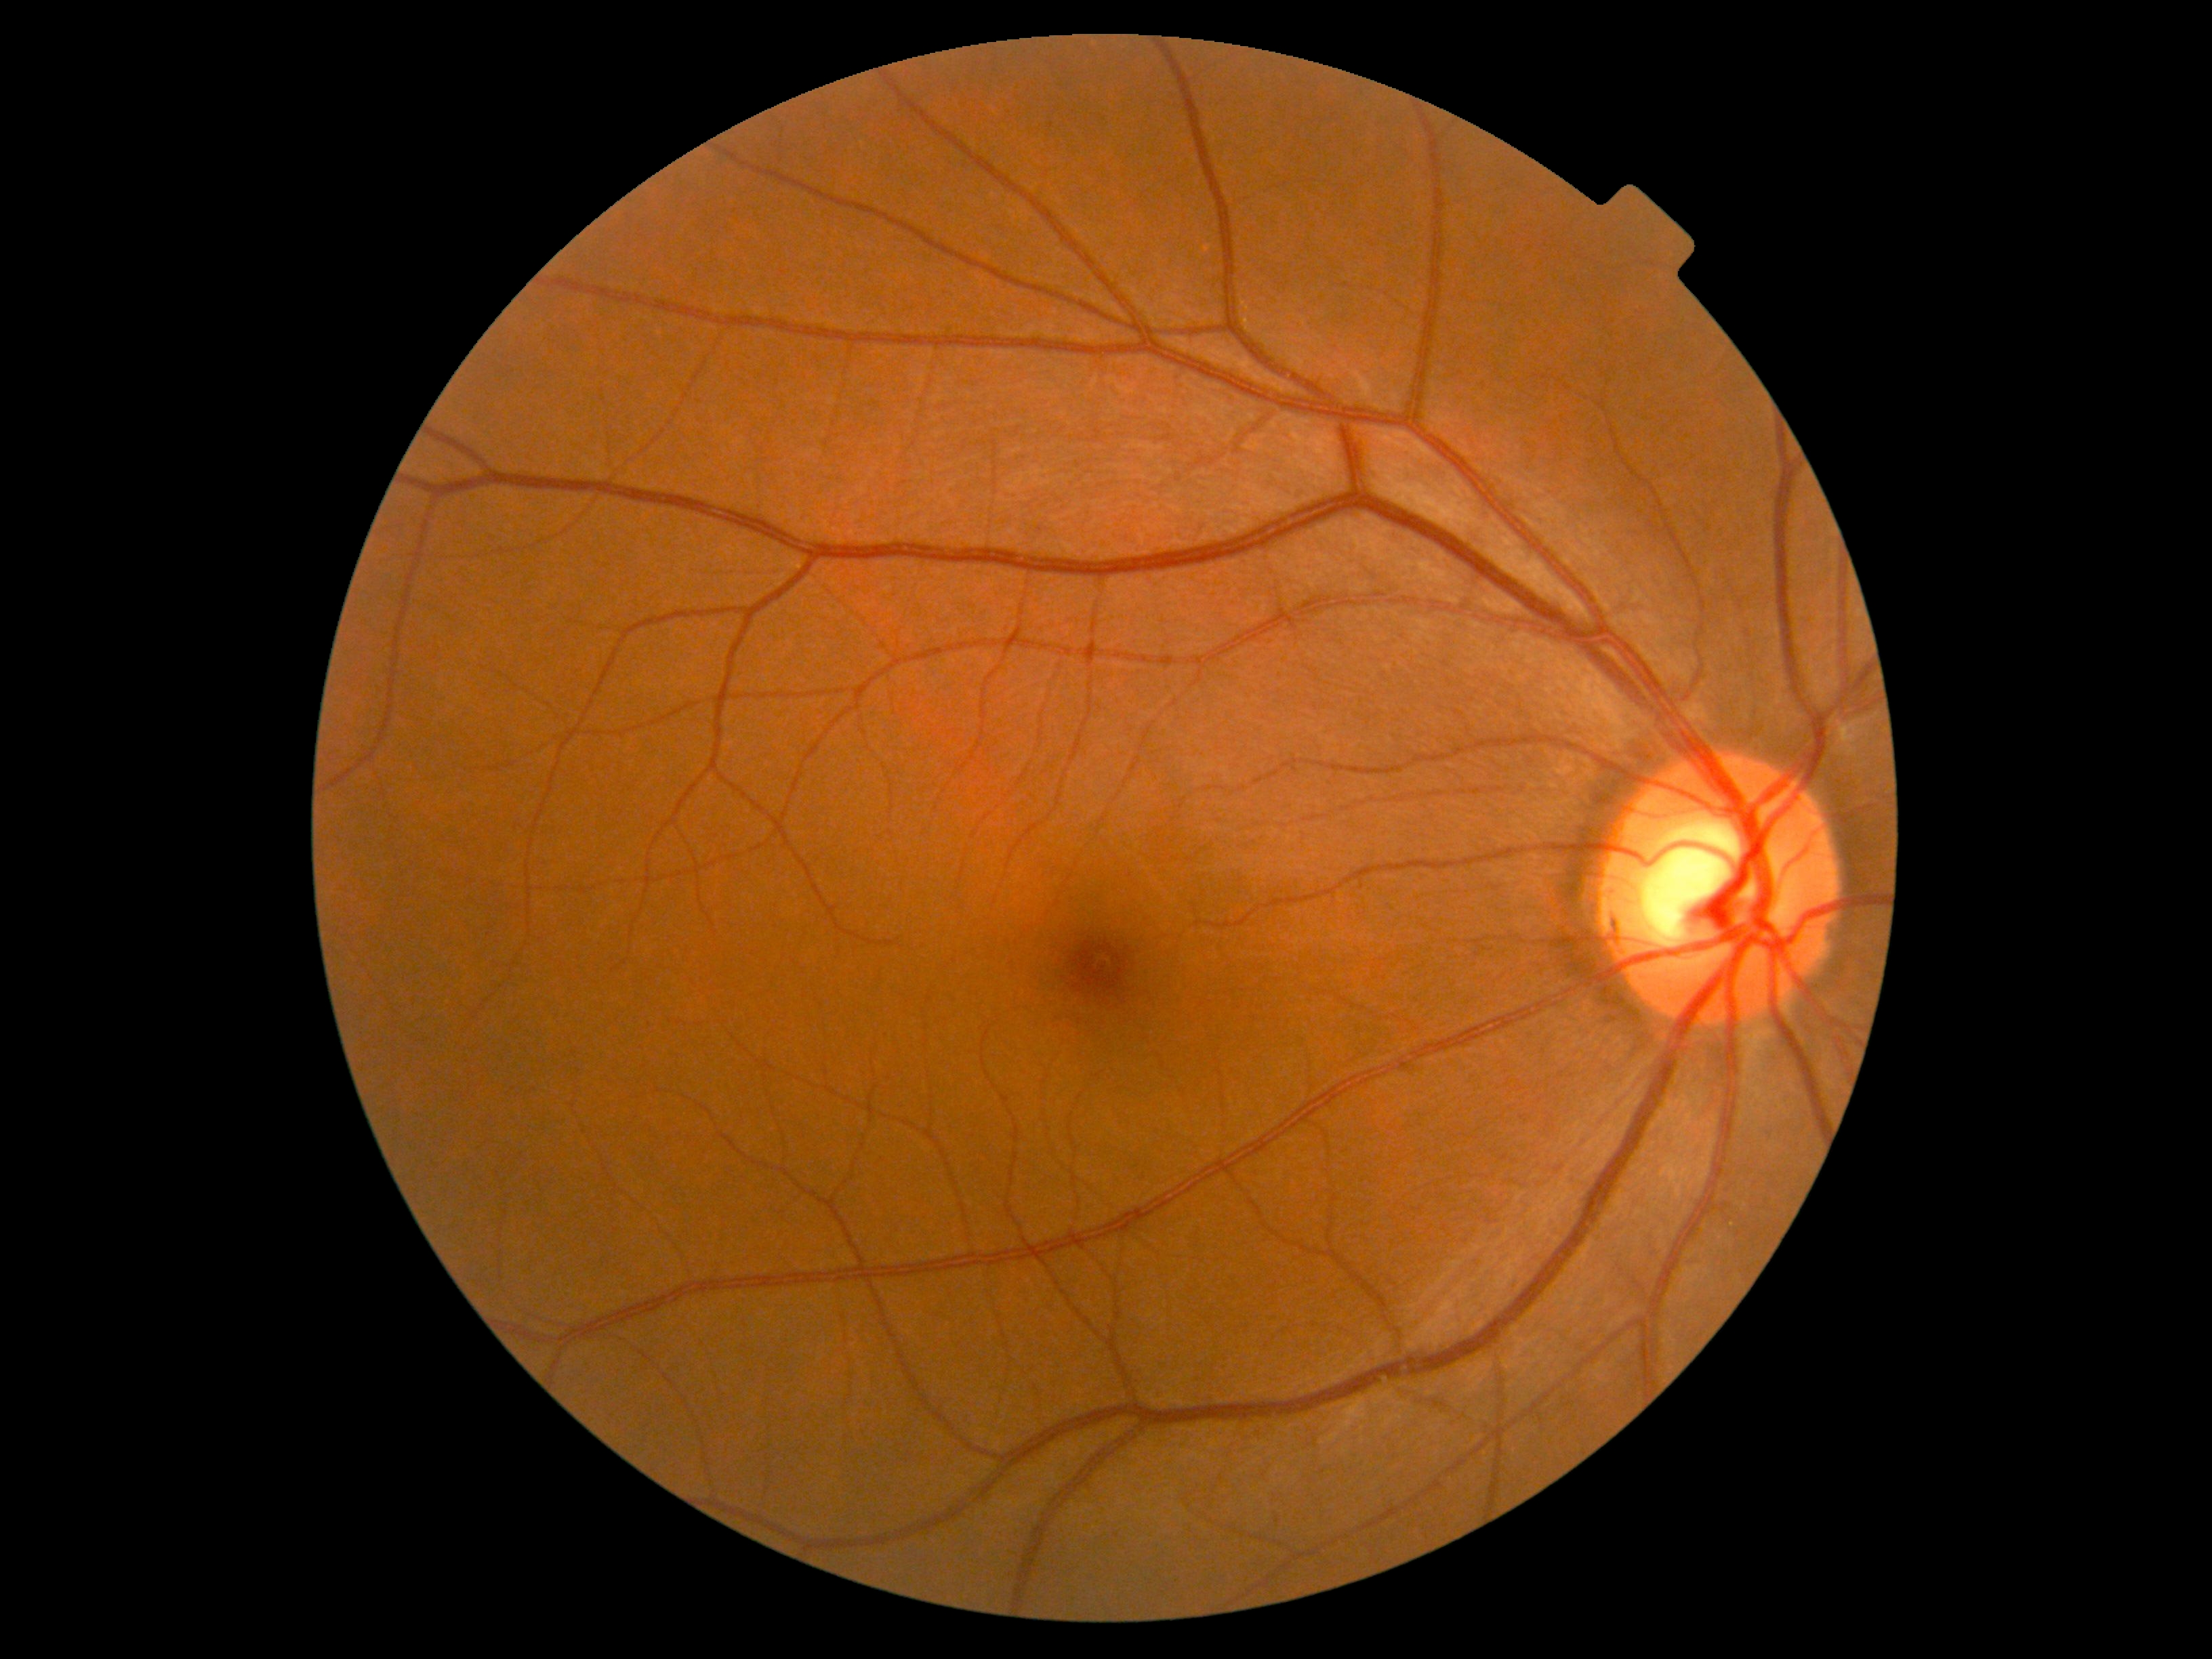

Diabetic retinopathy severity: grade 0 (no apparent retinopathy).